45° FOV, 1932 by 1932 pixels, CFP — 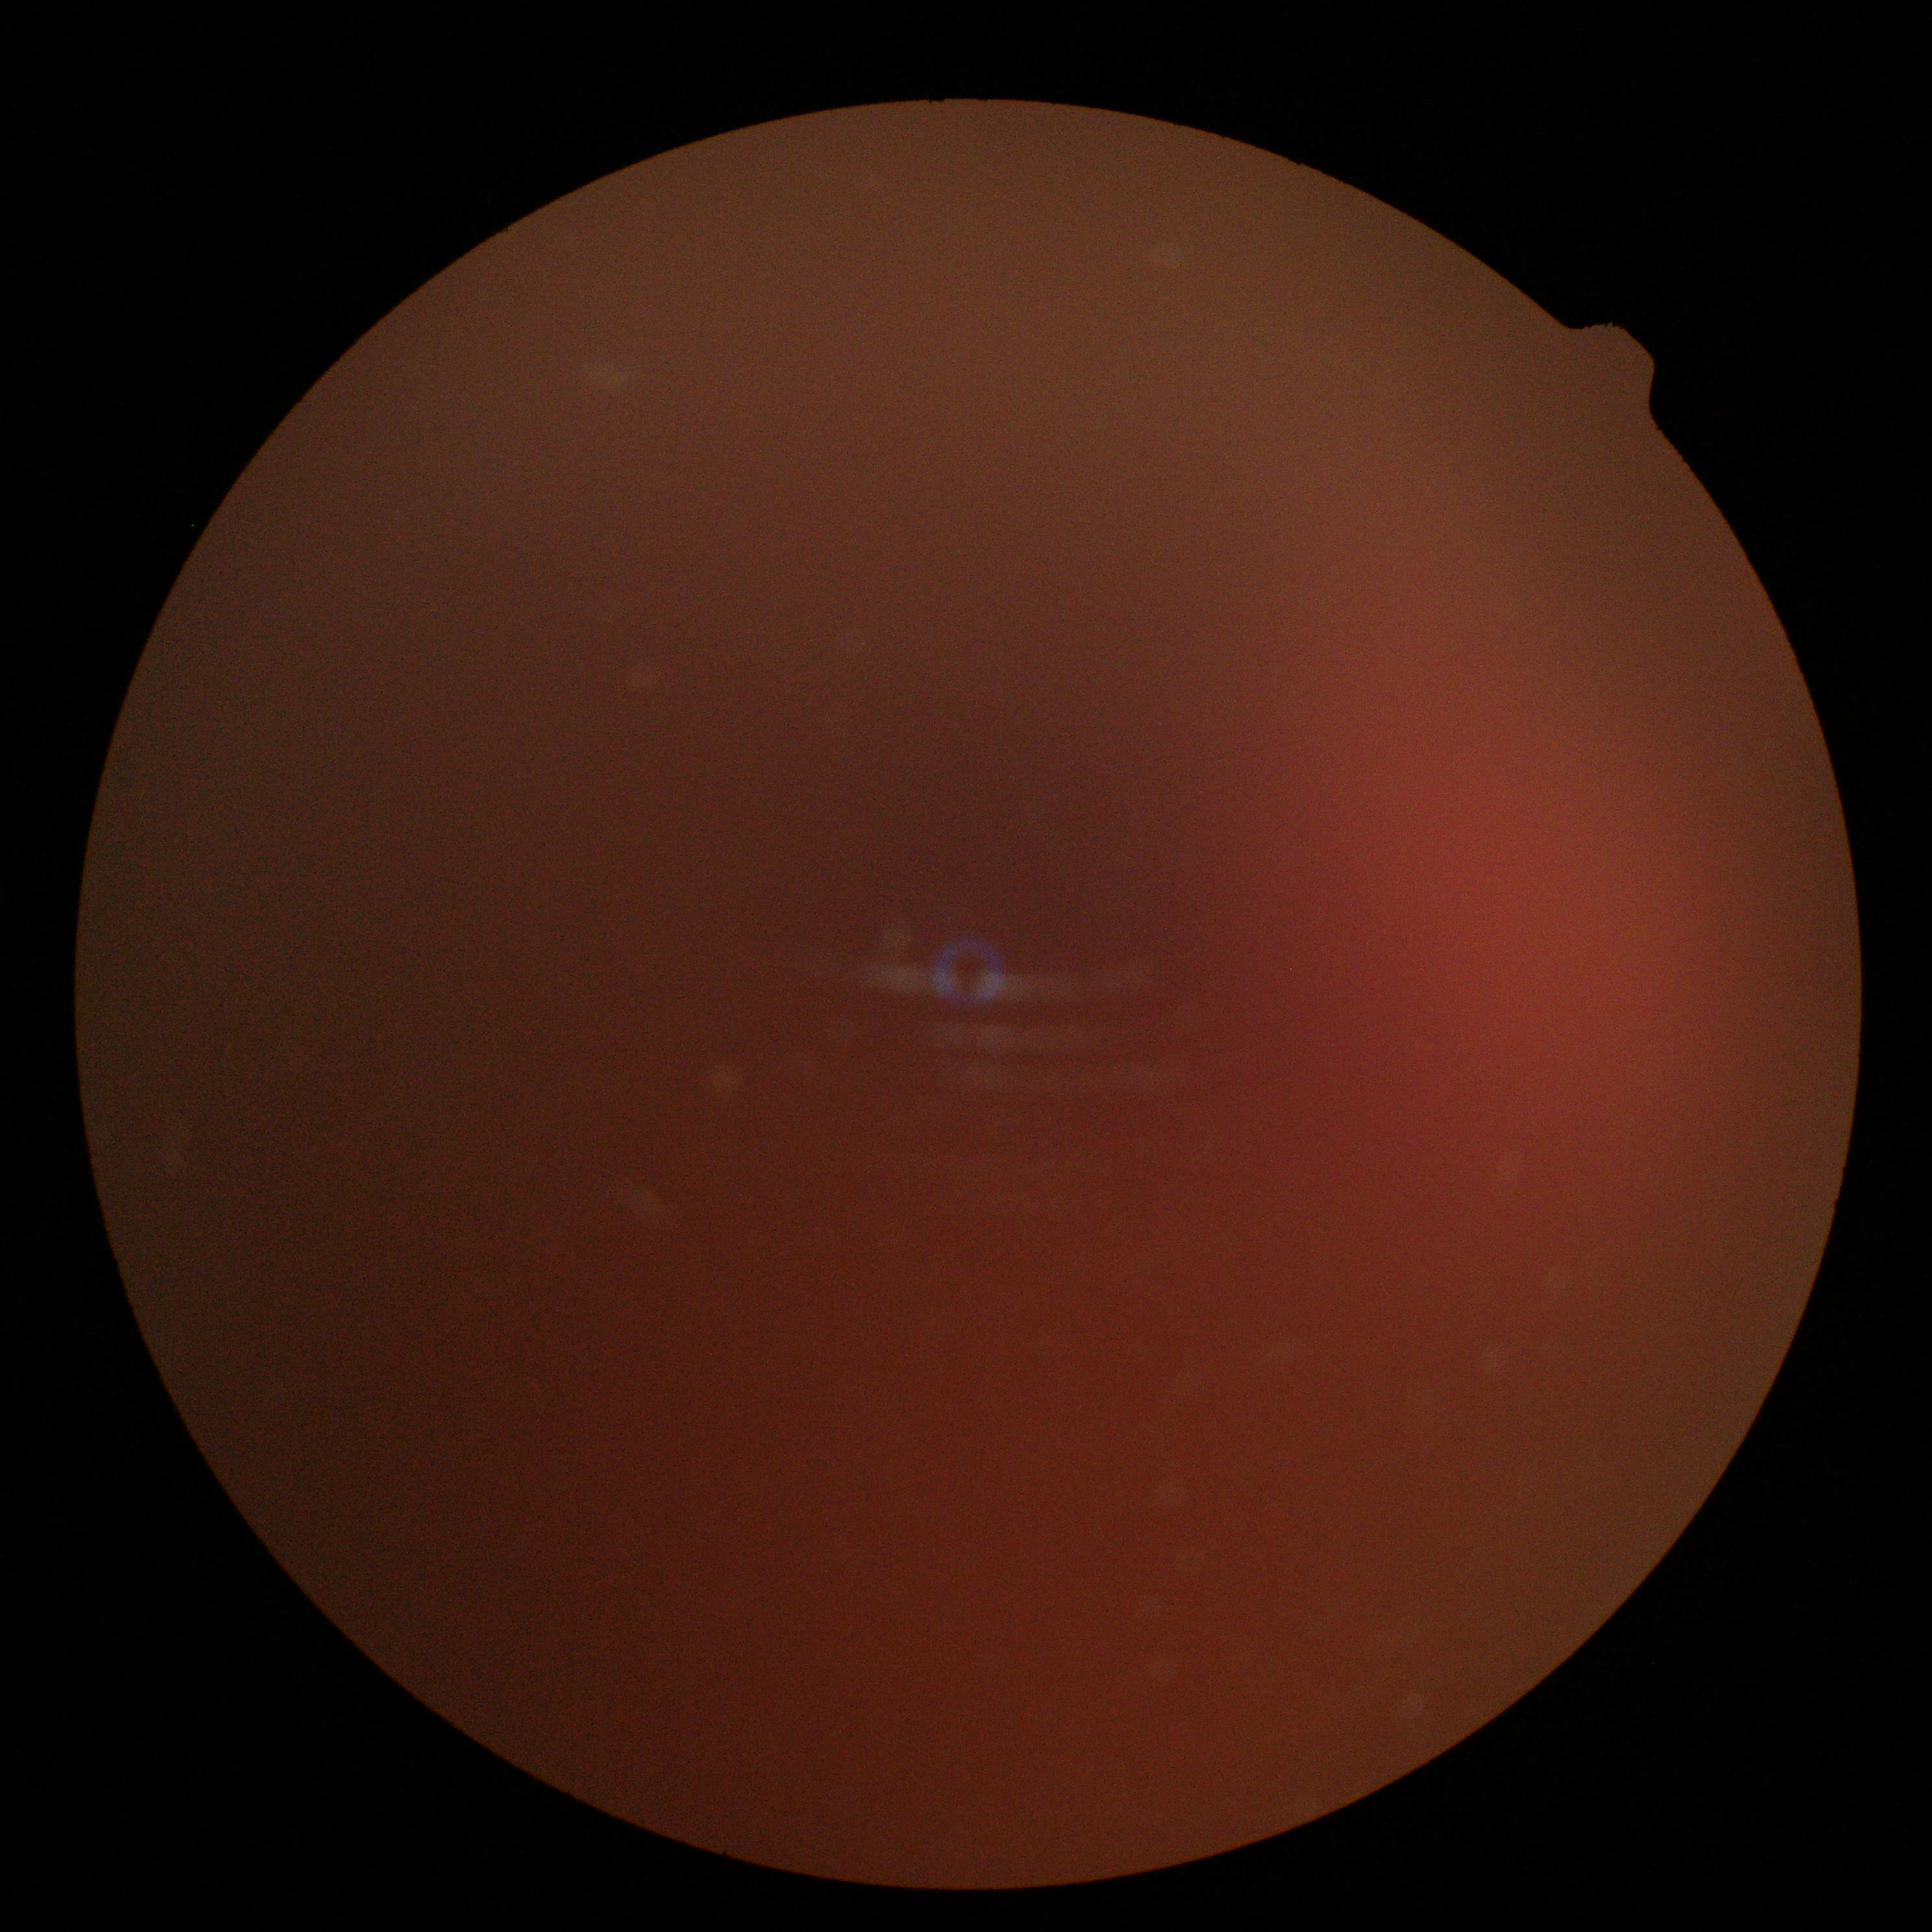 DR stage is ungradable due to poor image quality.